Retinal fundus photograph; 45-degree field of view; 2352 by 1568 pixels
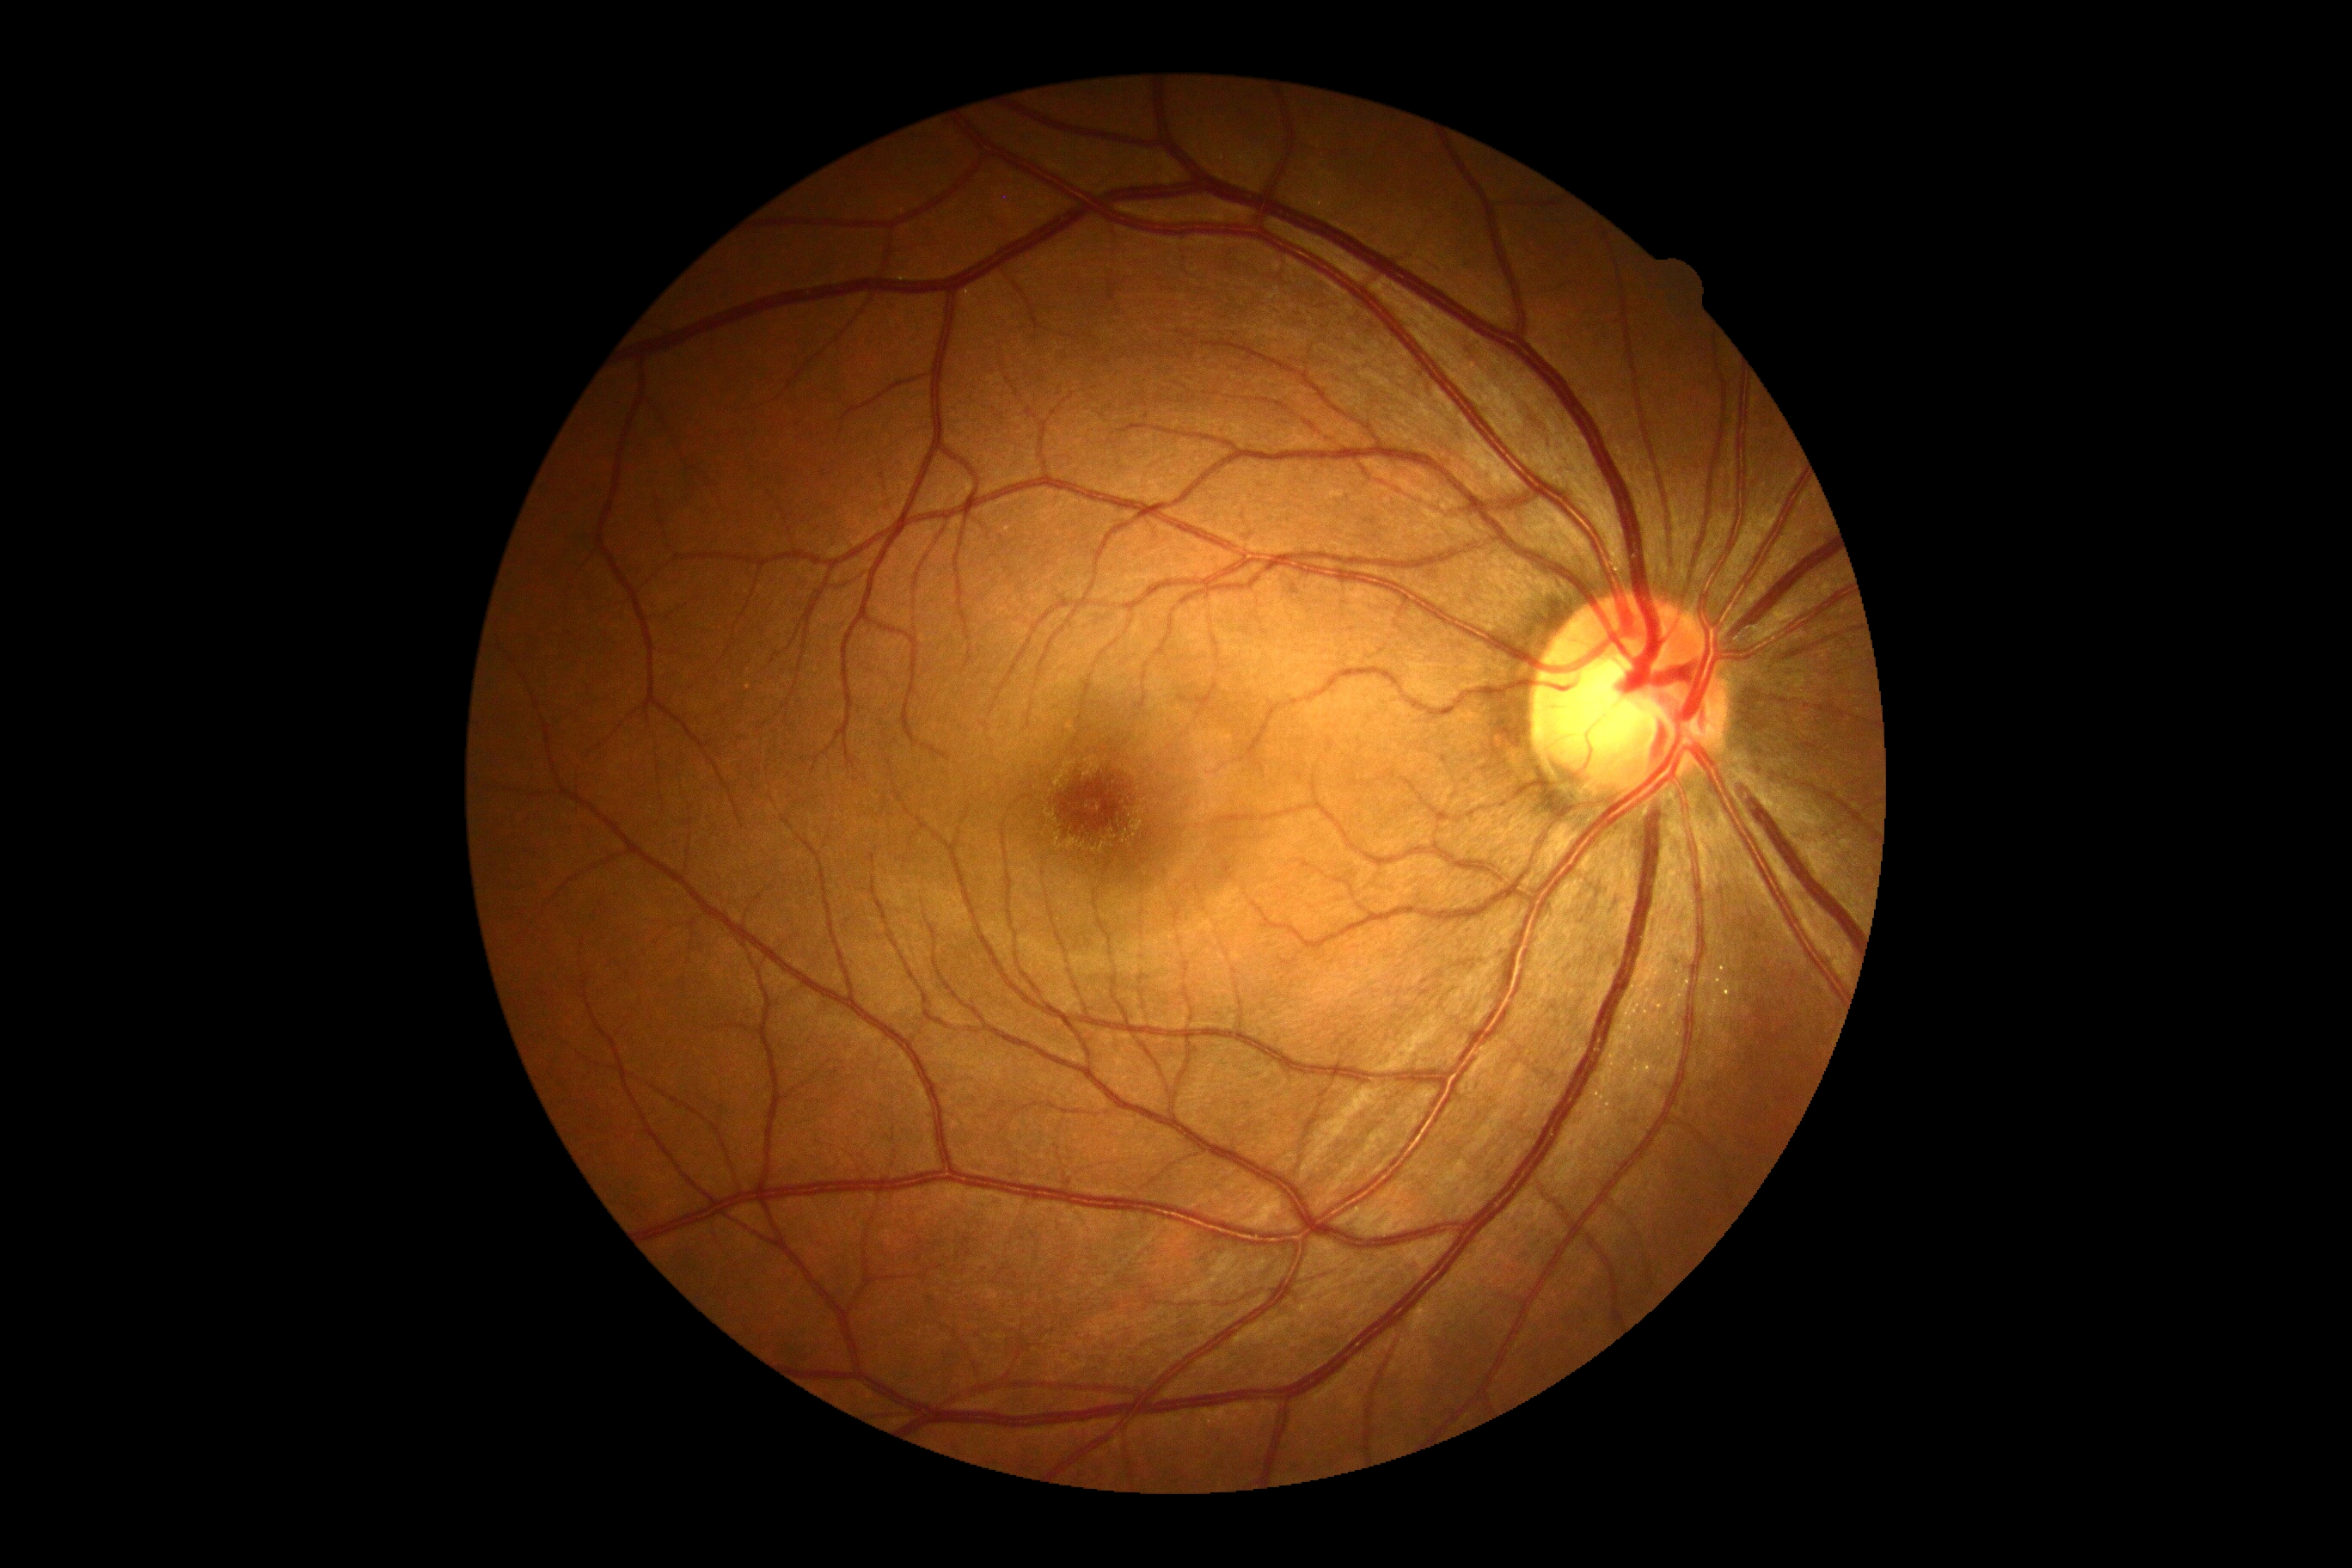 Annotations:
* DR impression — negative for DR
* diabetic retinopathy severity — grade 0